Wide-field retinal mosaic image.
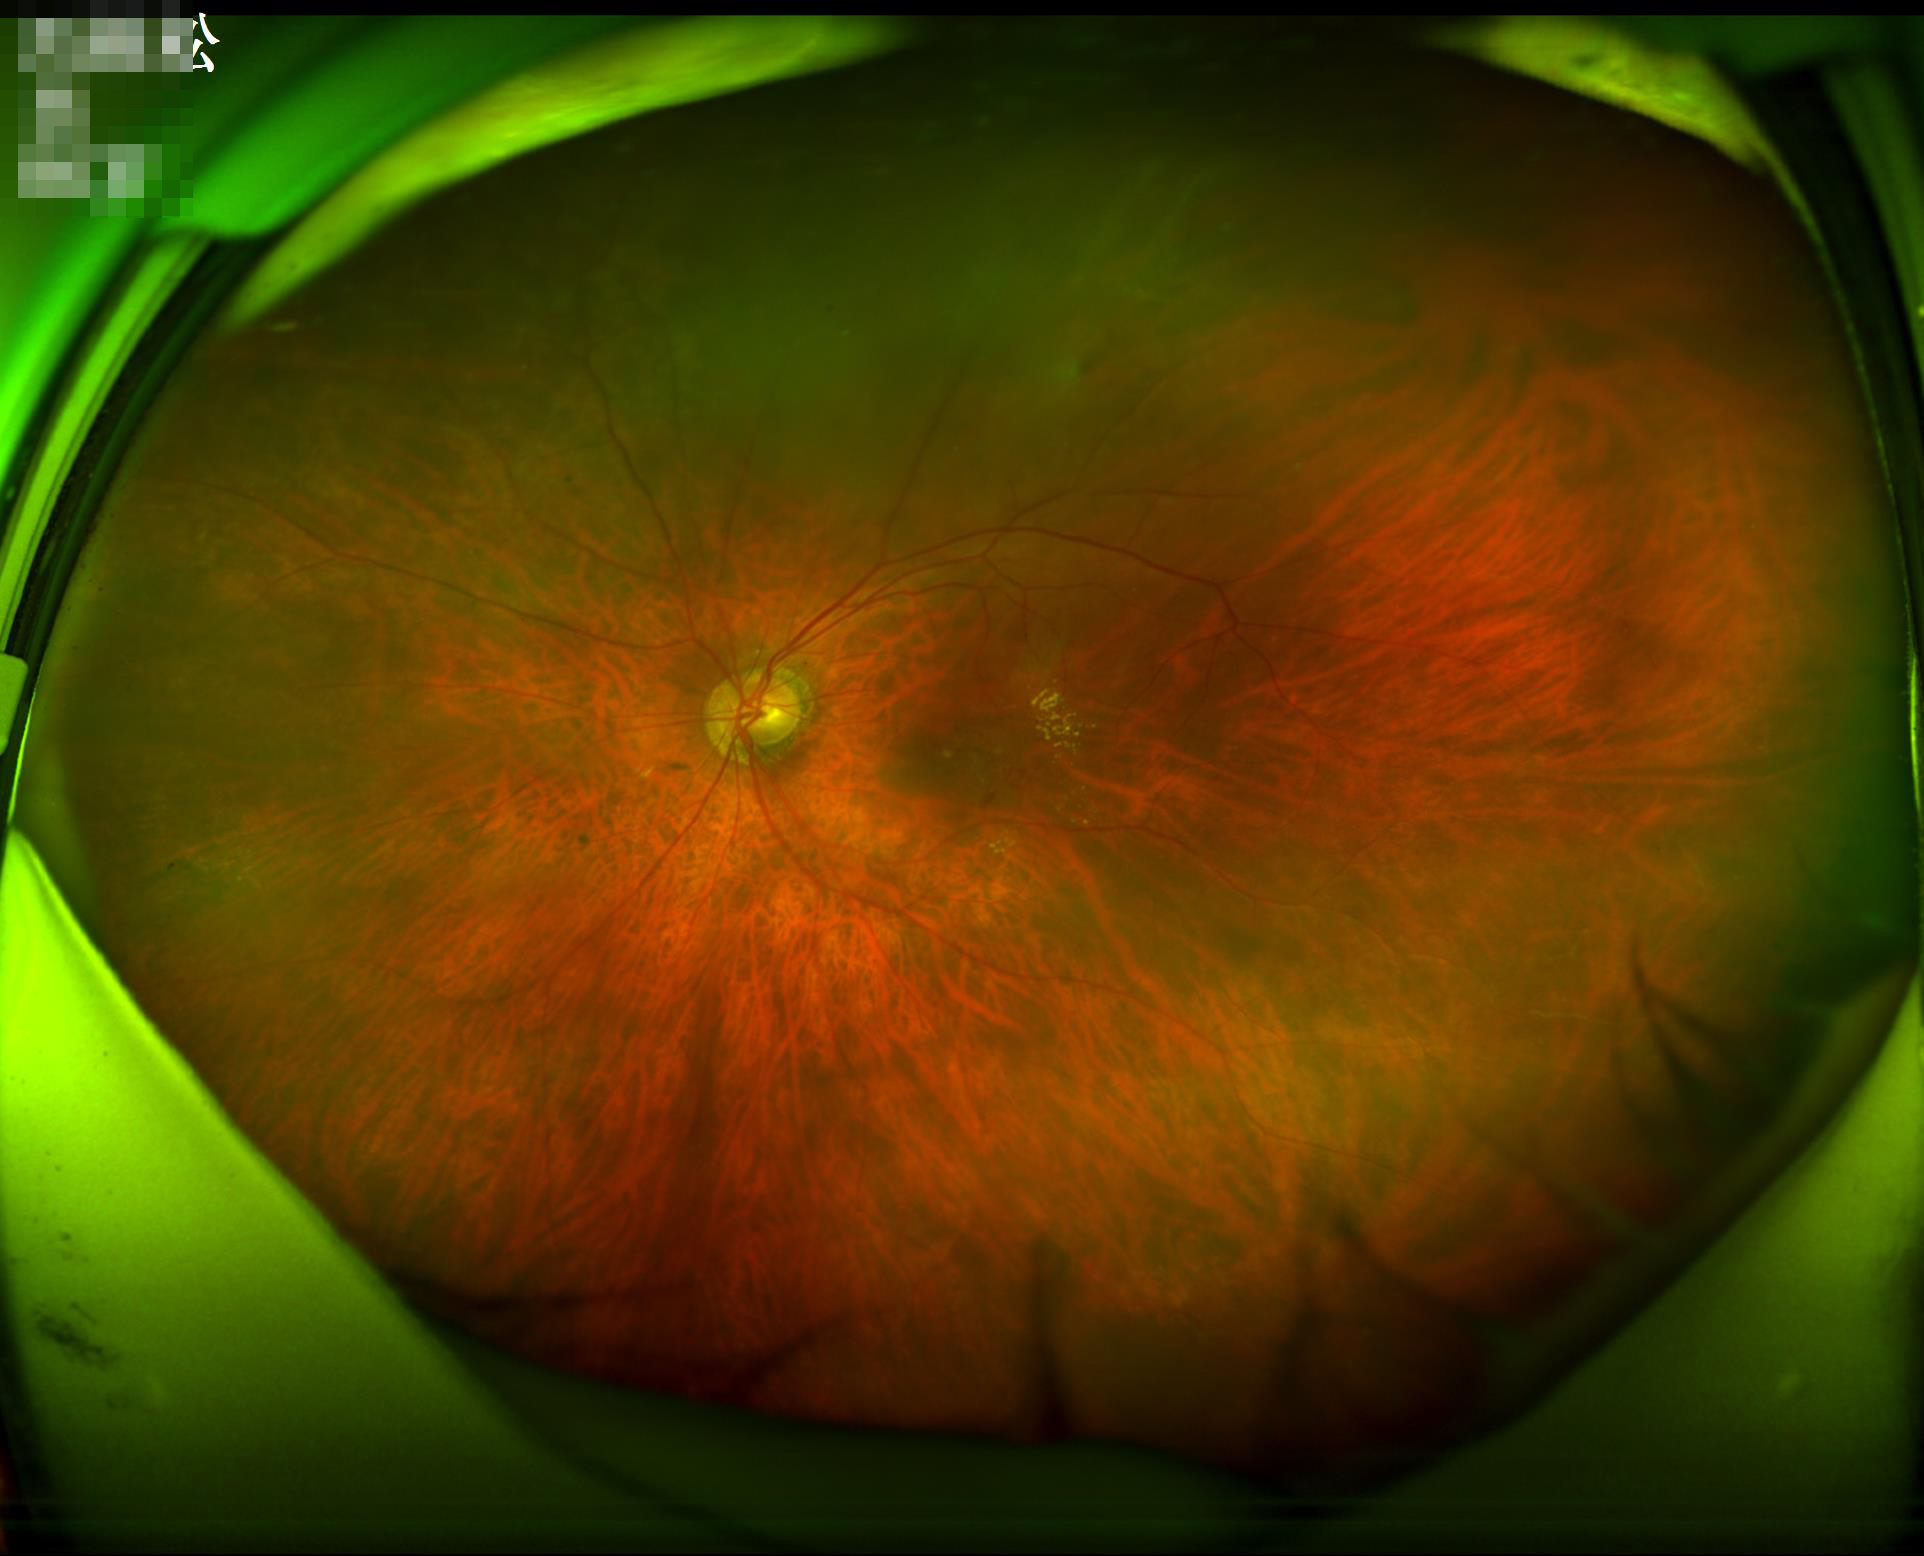 Vessels and details are readily distinguishable.